1659 by 2212 pixels:
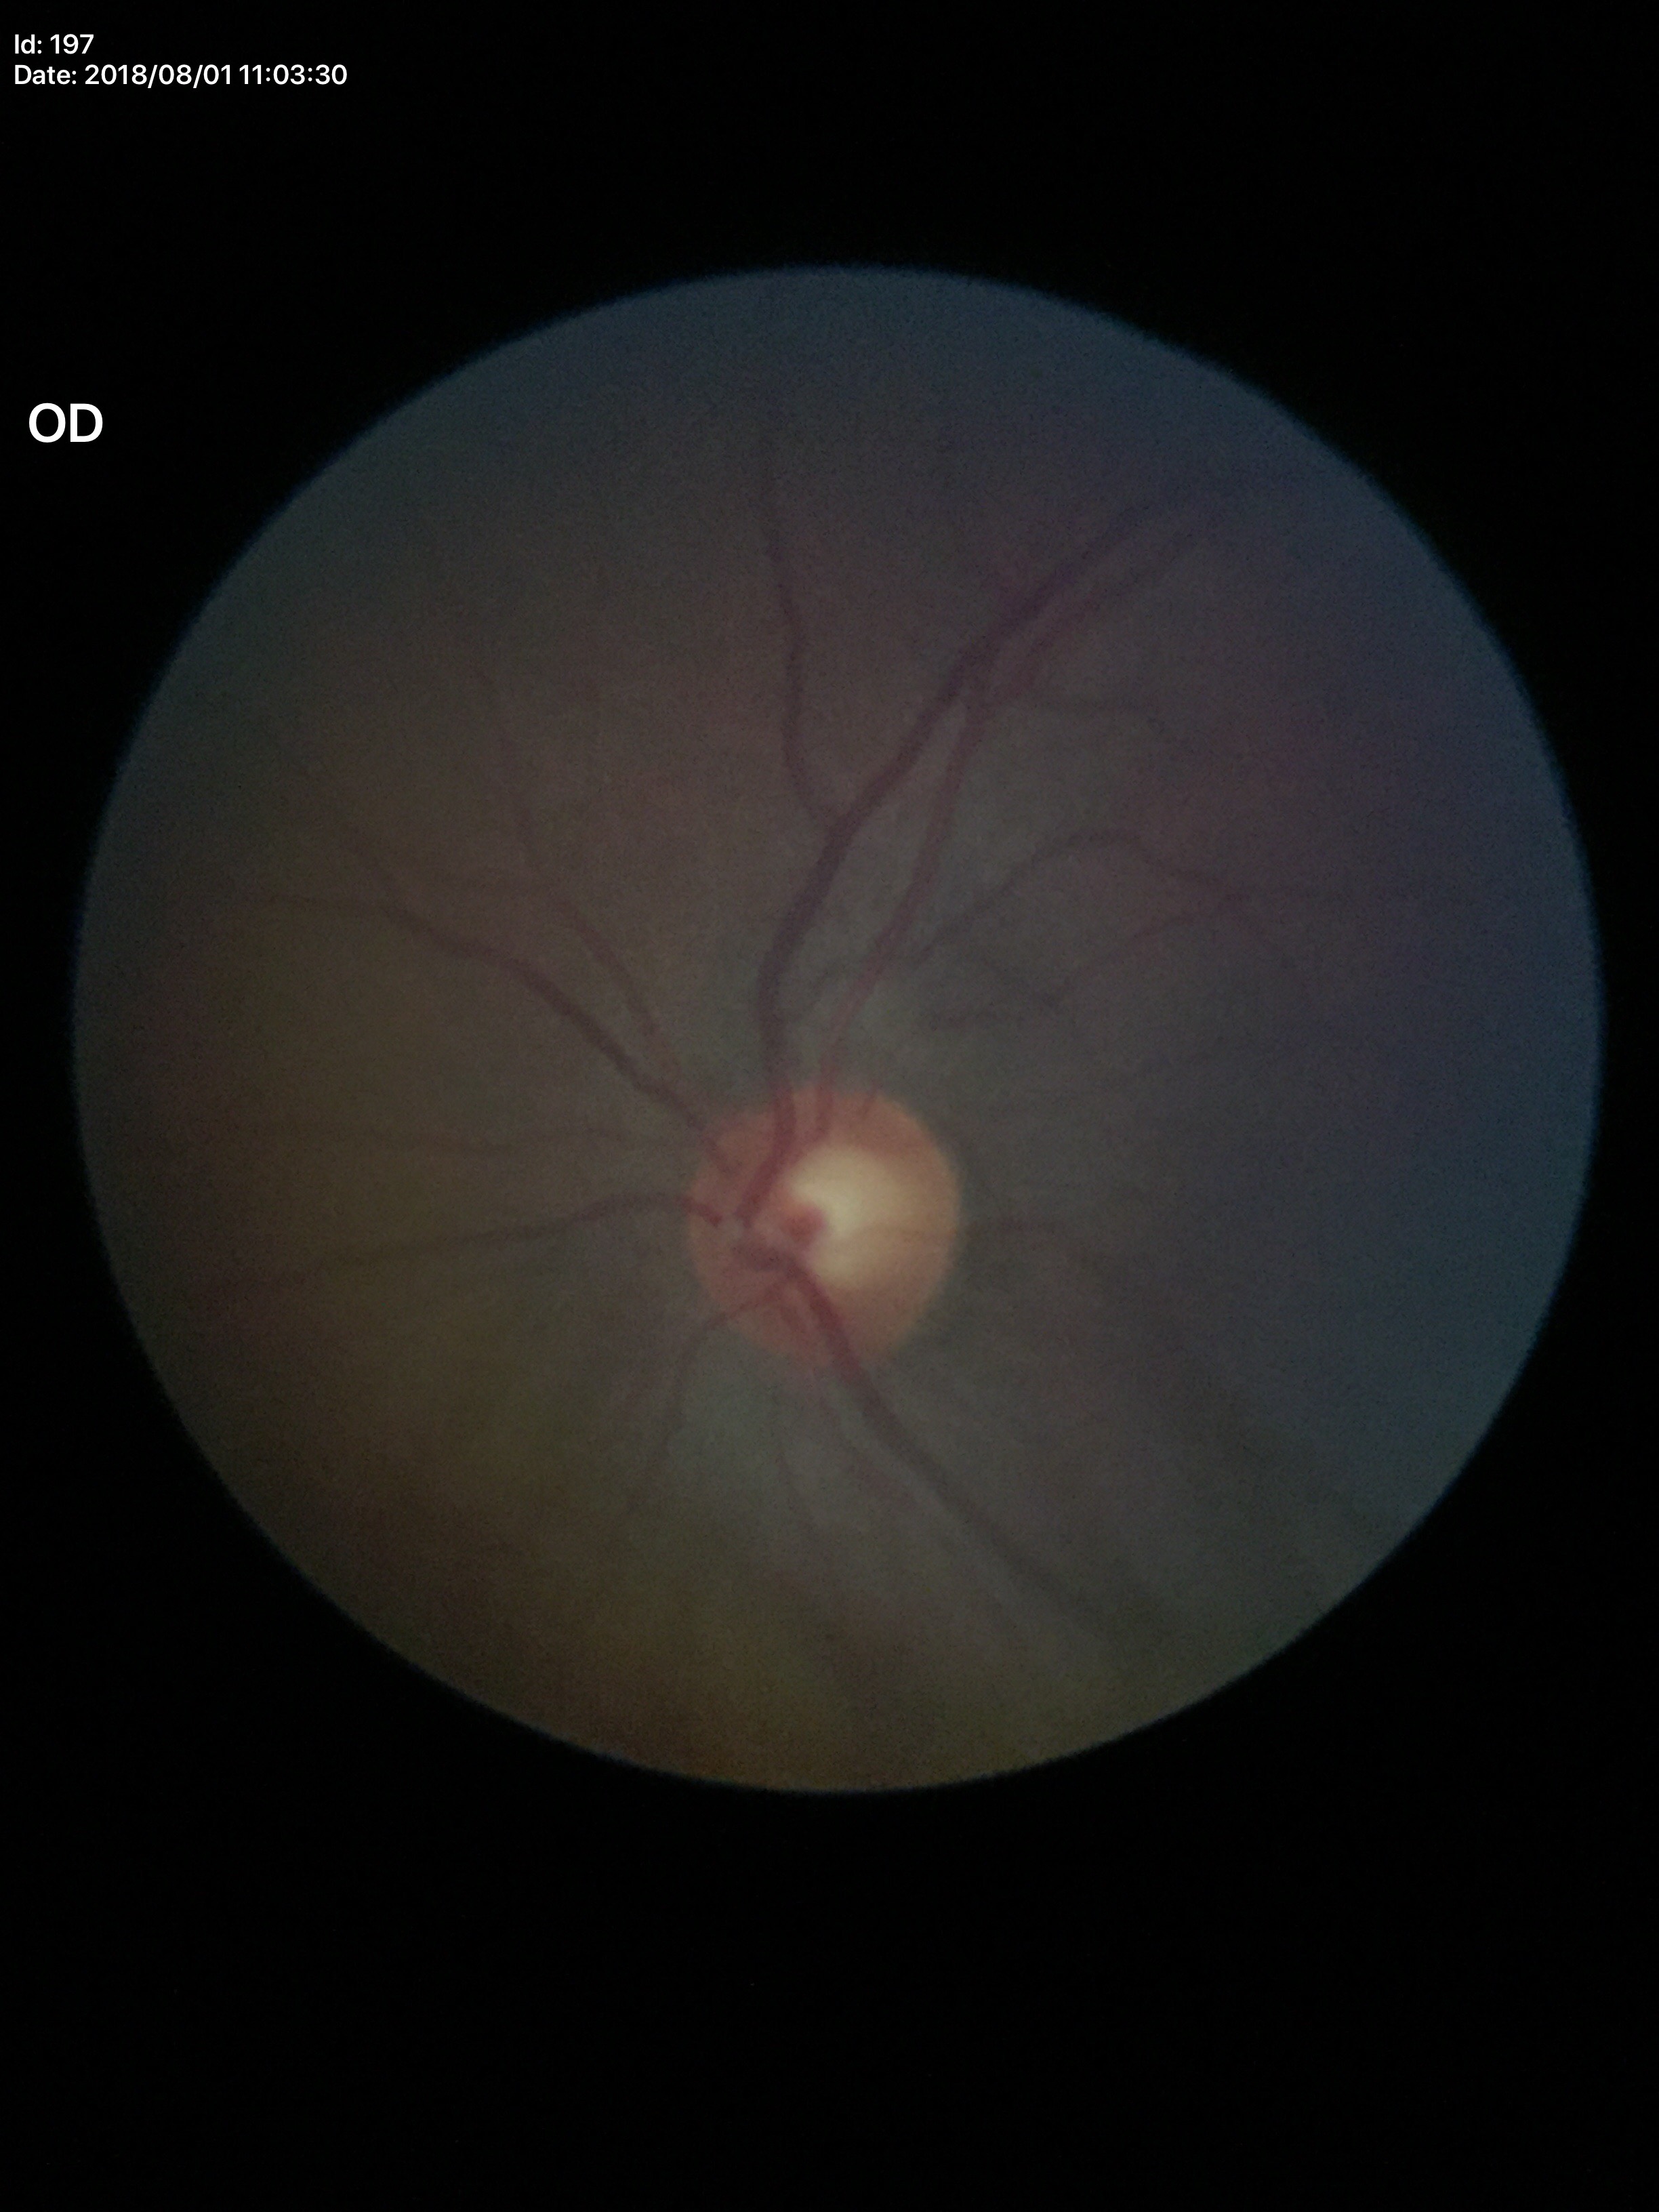

{"glaucoma_decision": "no suspicious findings", "vcdr": "0.58"}